Color fundus photograph — 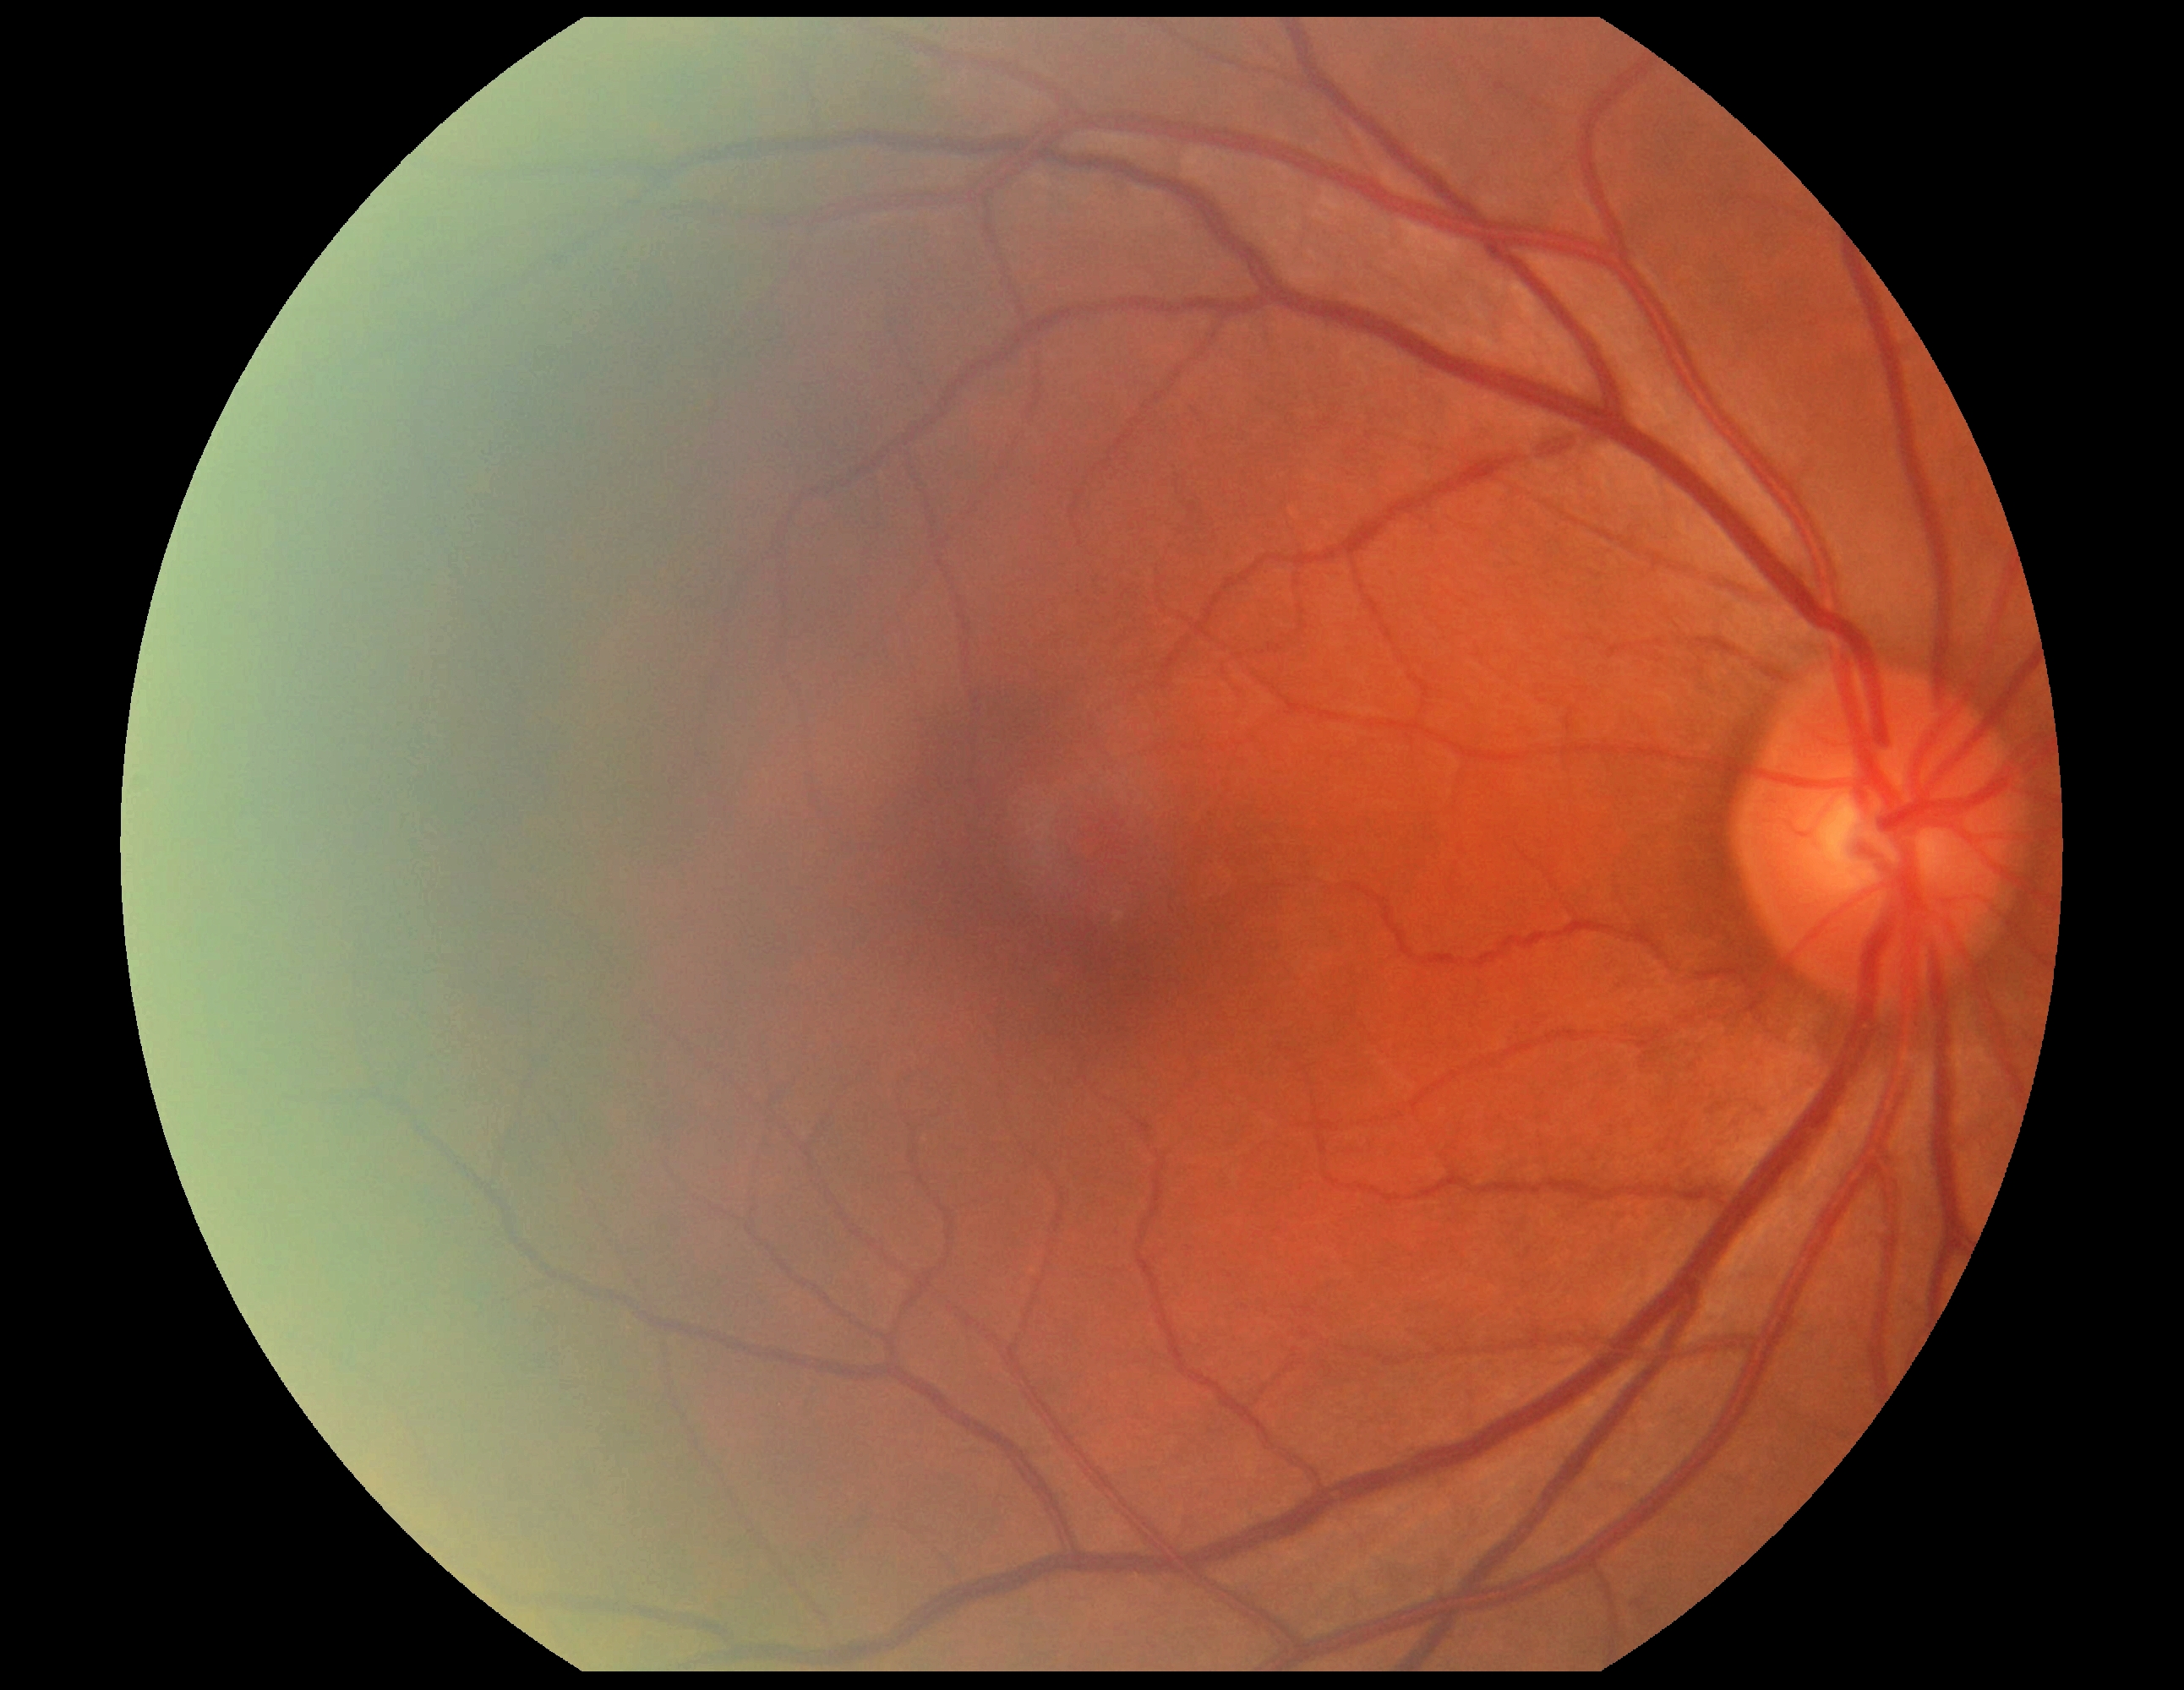

dr_grade: no apparent retinopathy (grade 0)